Gender: M. Axial length (AL): 25.64 mm. Patient age: 62 years. Image size 2212x1661. Pachymetry: 497 µm. CFP. Intraocular pressure (IOP) 15 mmHg. Camera: Topcon TRC-NW400. 30° FOV:
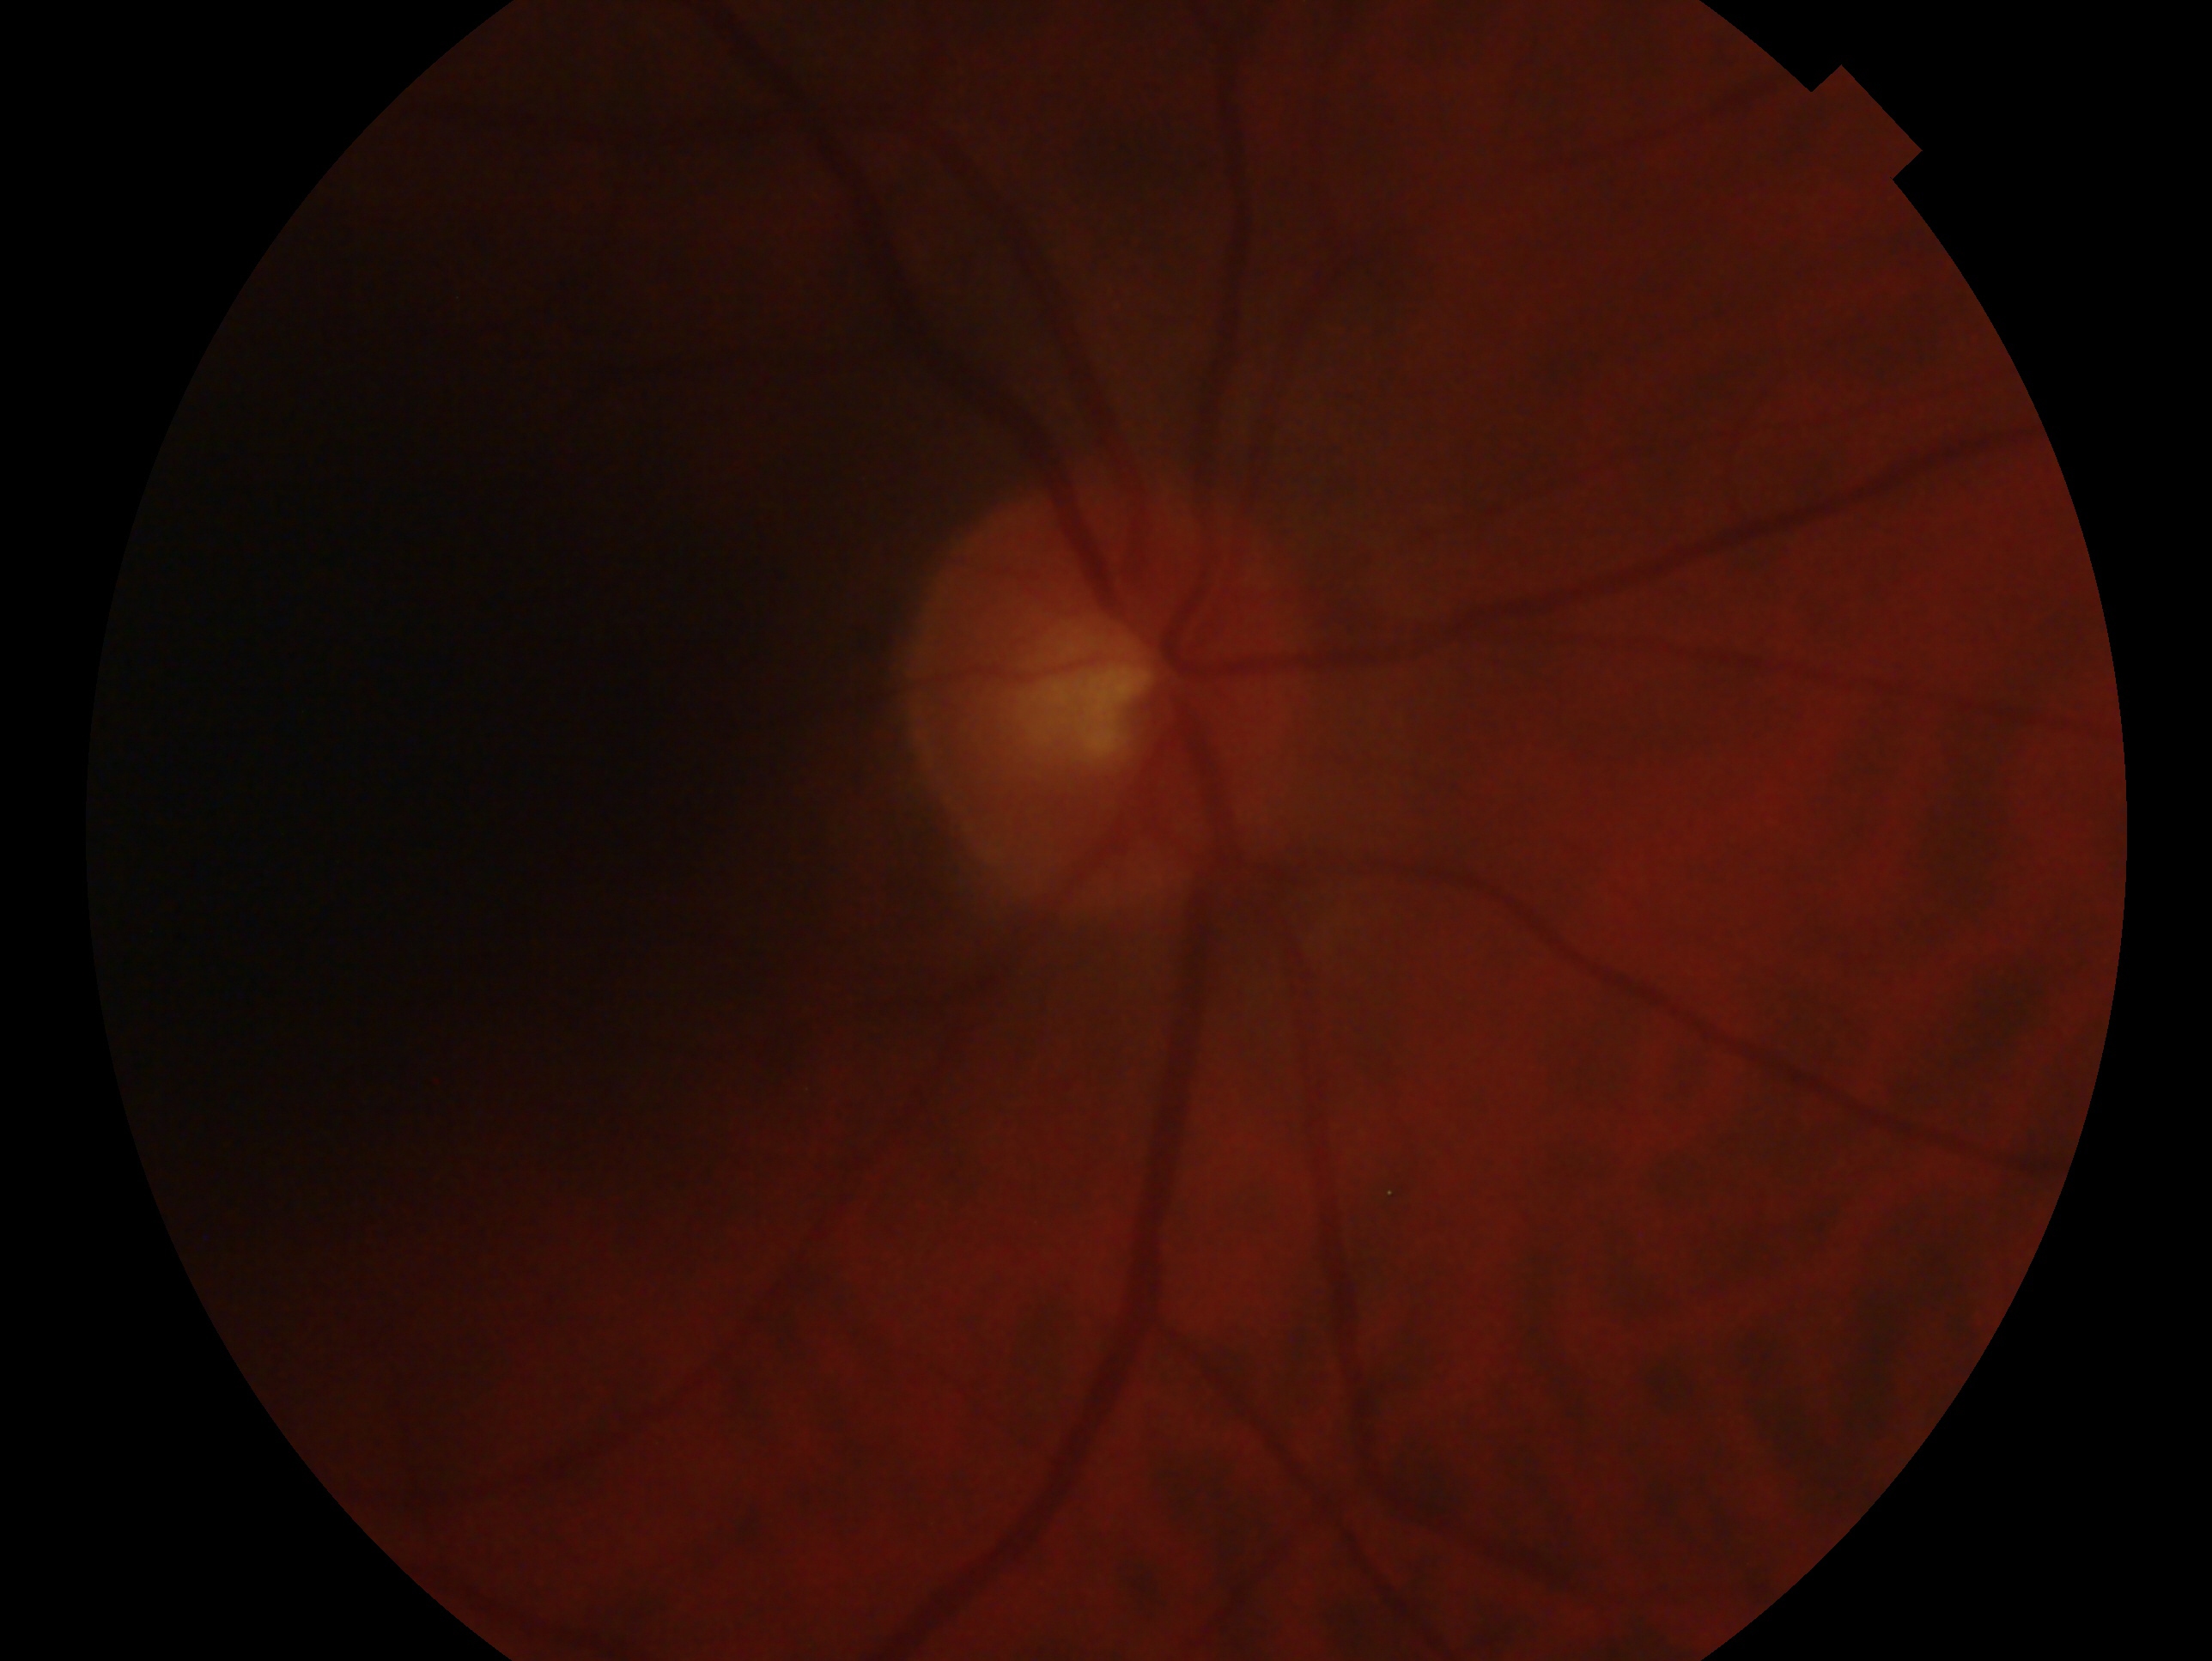 glaucoma_dx: no evidence of glaucoma
eye: oculus dexter